Retinal fundus photograph:
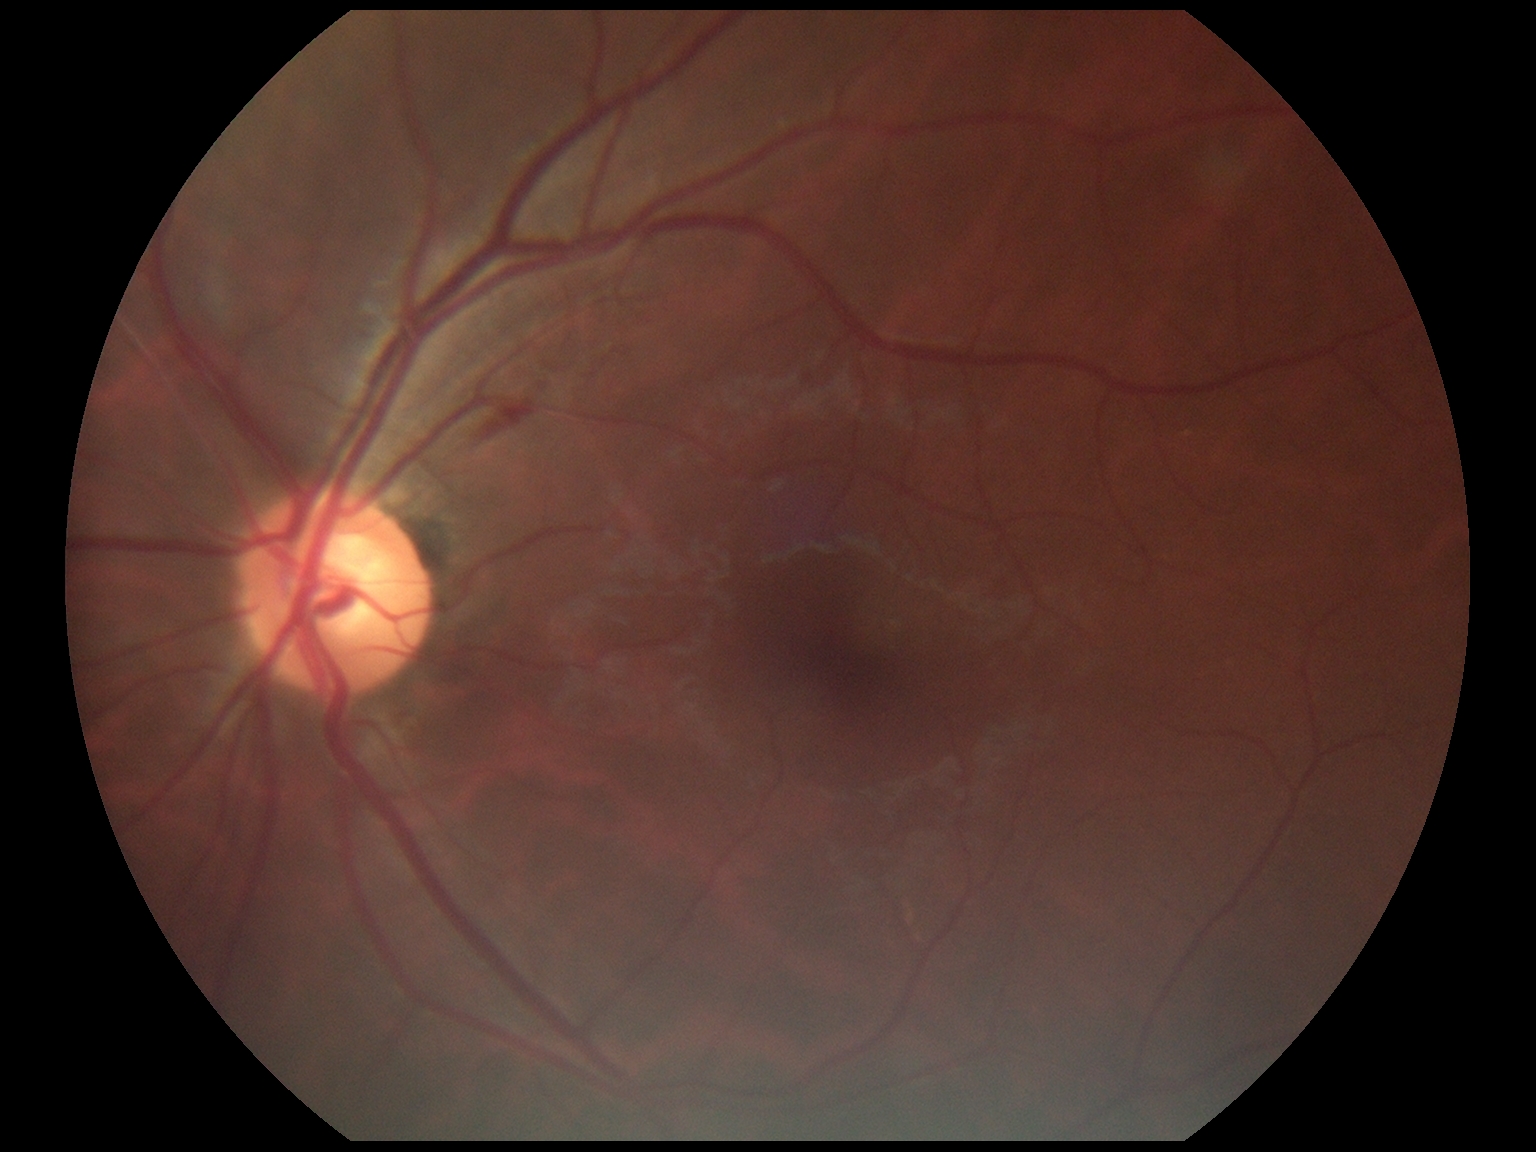 DR: moderate NPDR (grade 2).